Pediatric retinal photograph (wide-field):
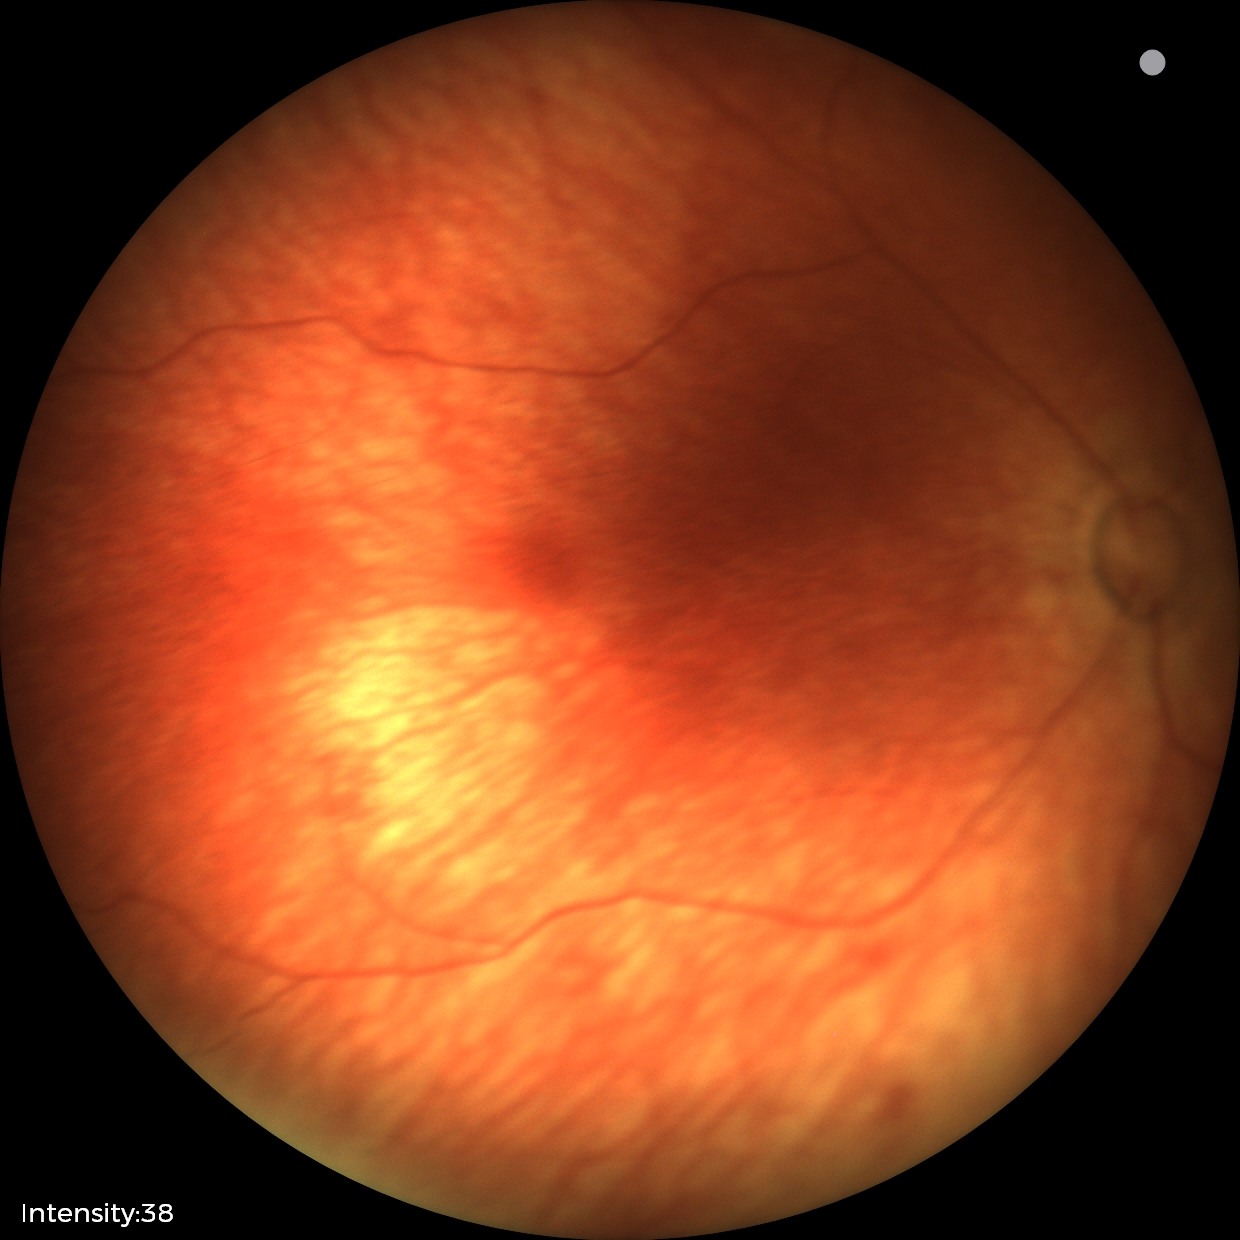
Q: What is the screening diagnosis?
A: no abnormal retinal findings